Modified Davis classification, FOV: 45 degrees, 848 by 848 pixels, posterior pole photograph — 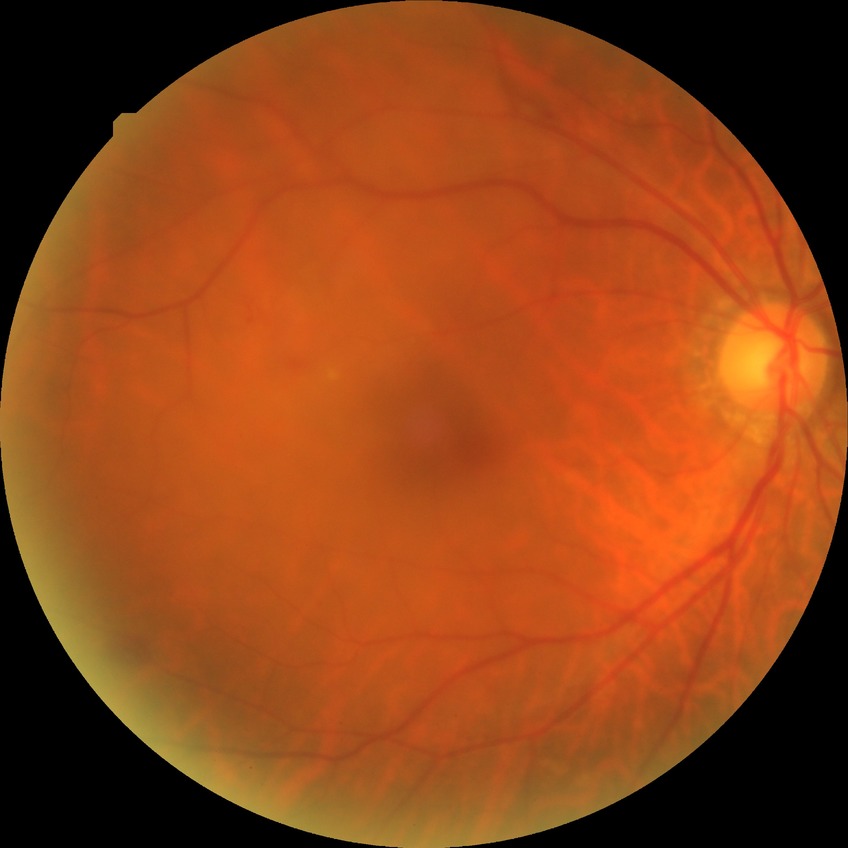

  davis_grade: no diabetic retinopathy